1971x1876px: 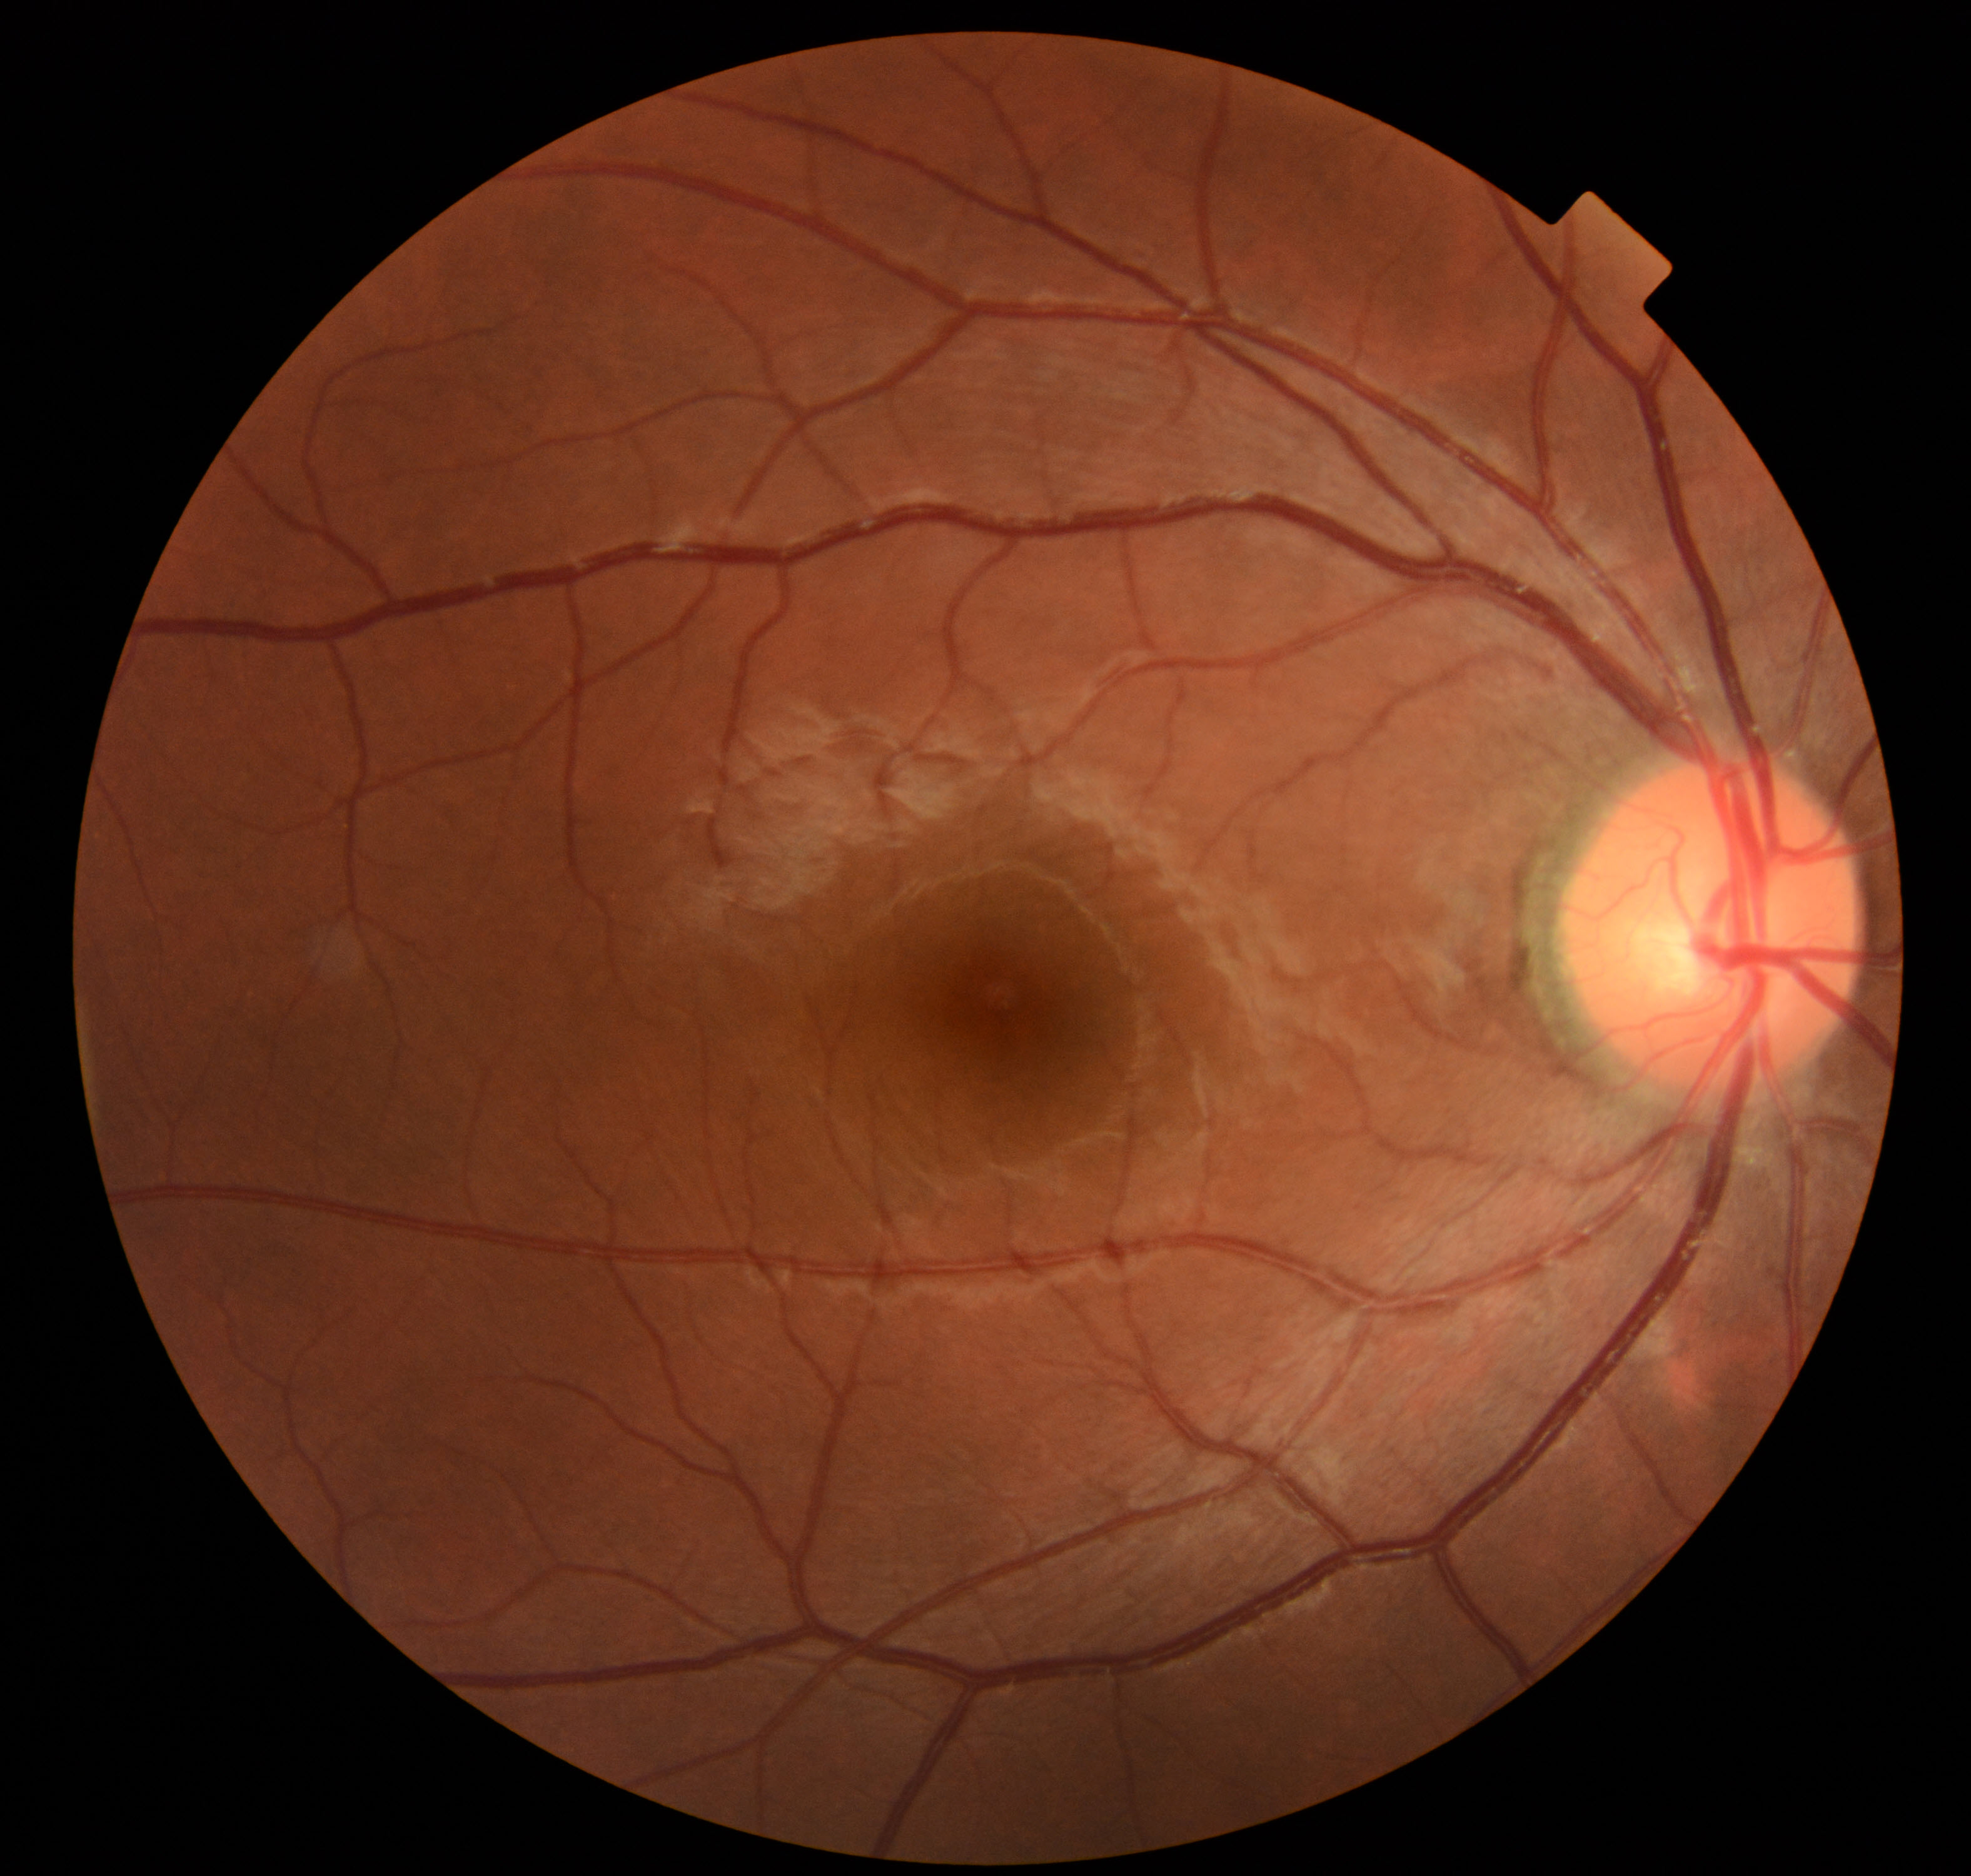 Diagnosis: normal.